Davis DR grading — 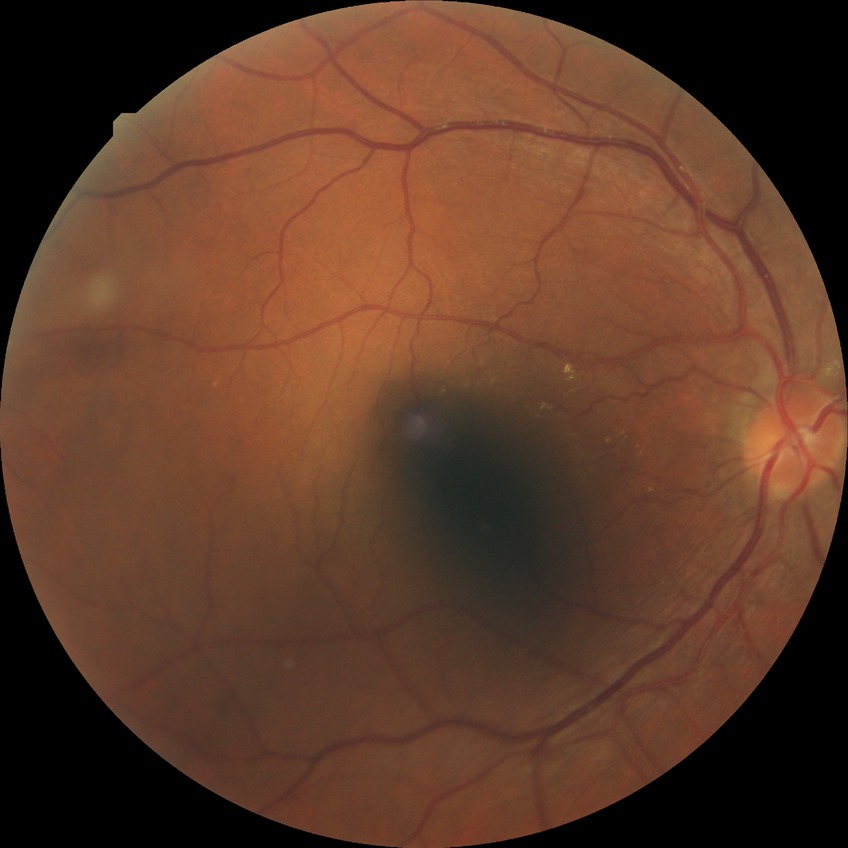 Diabetic retinopathy (DR) is no diabetic retinopathy (NDR).